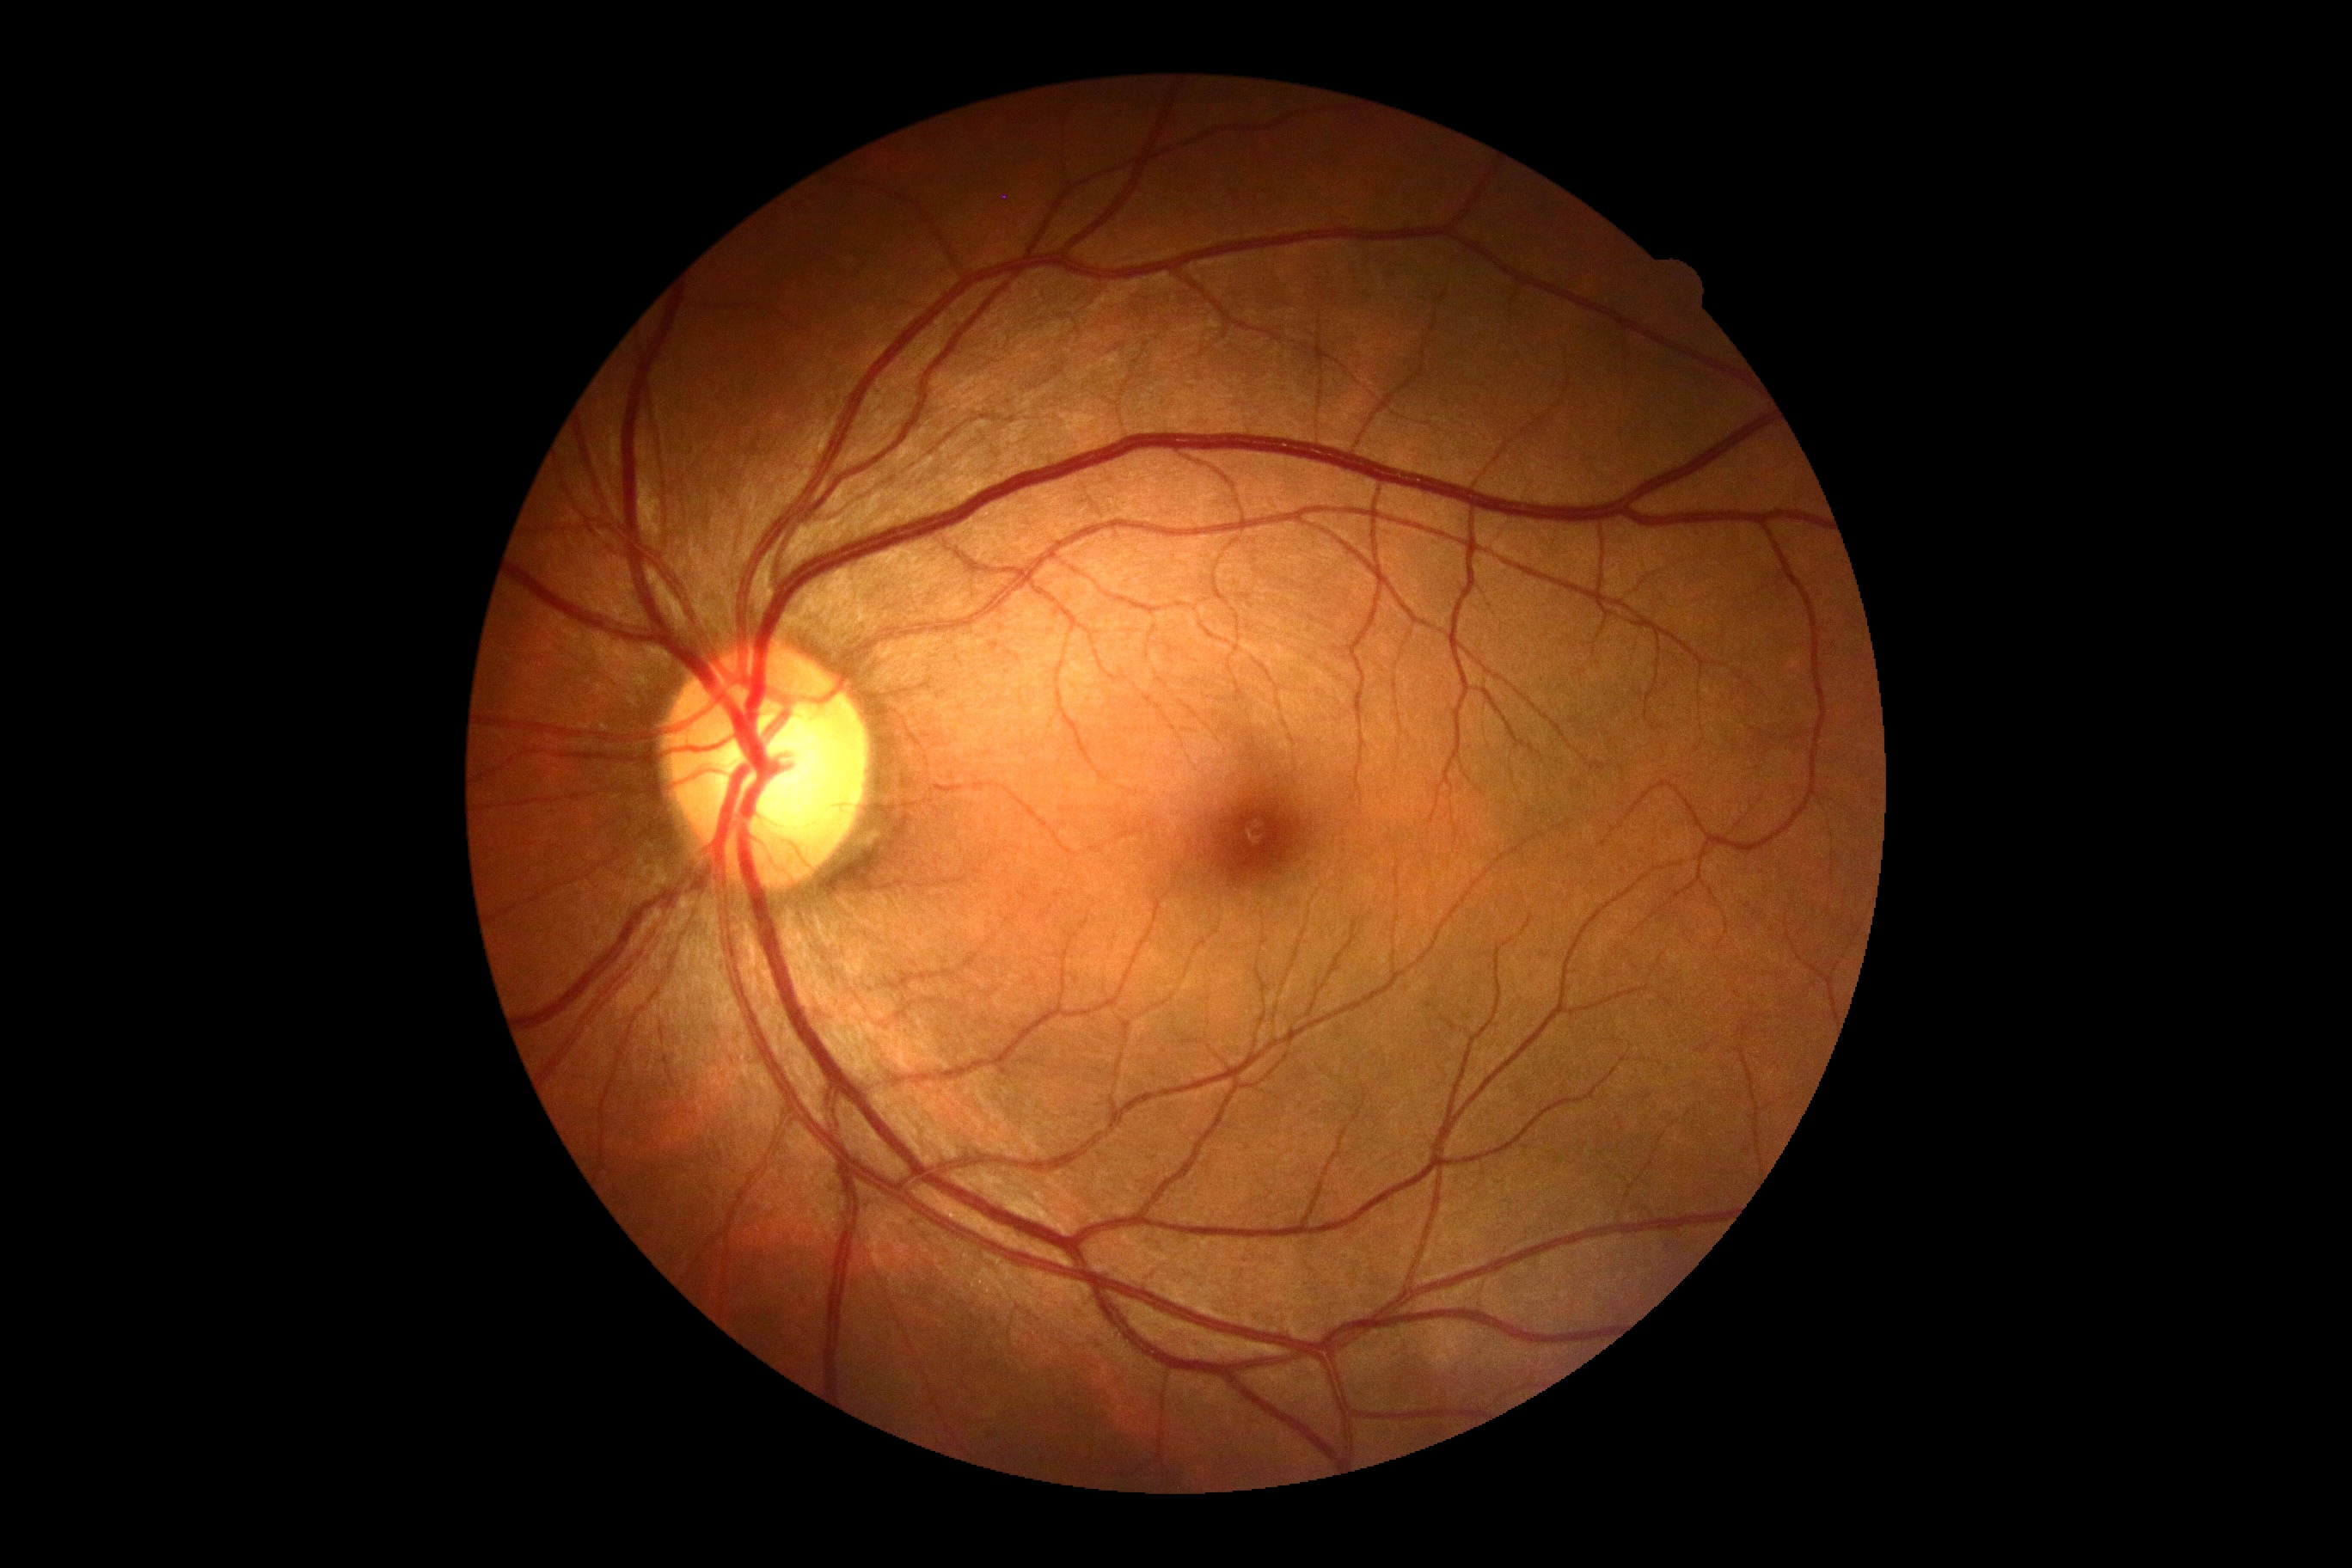

Diabetic retinopathy severity is no apparent diabetic retinopathy (grade 0).